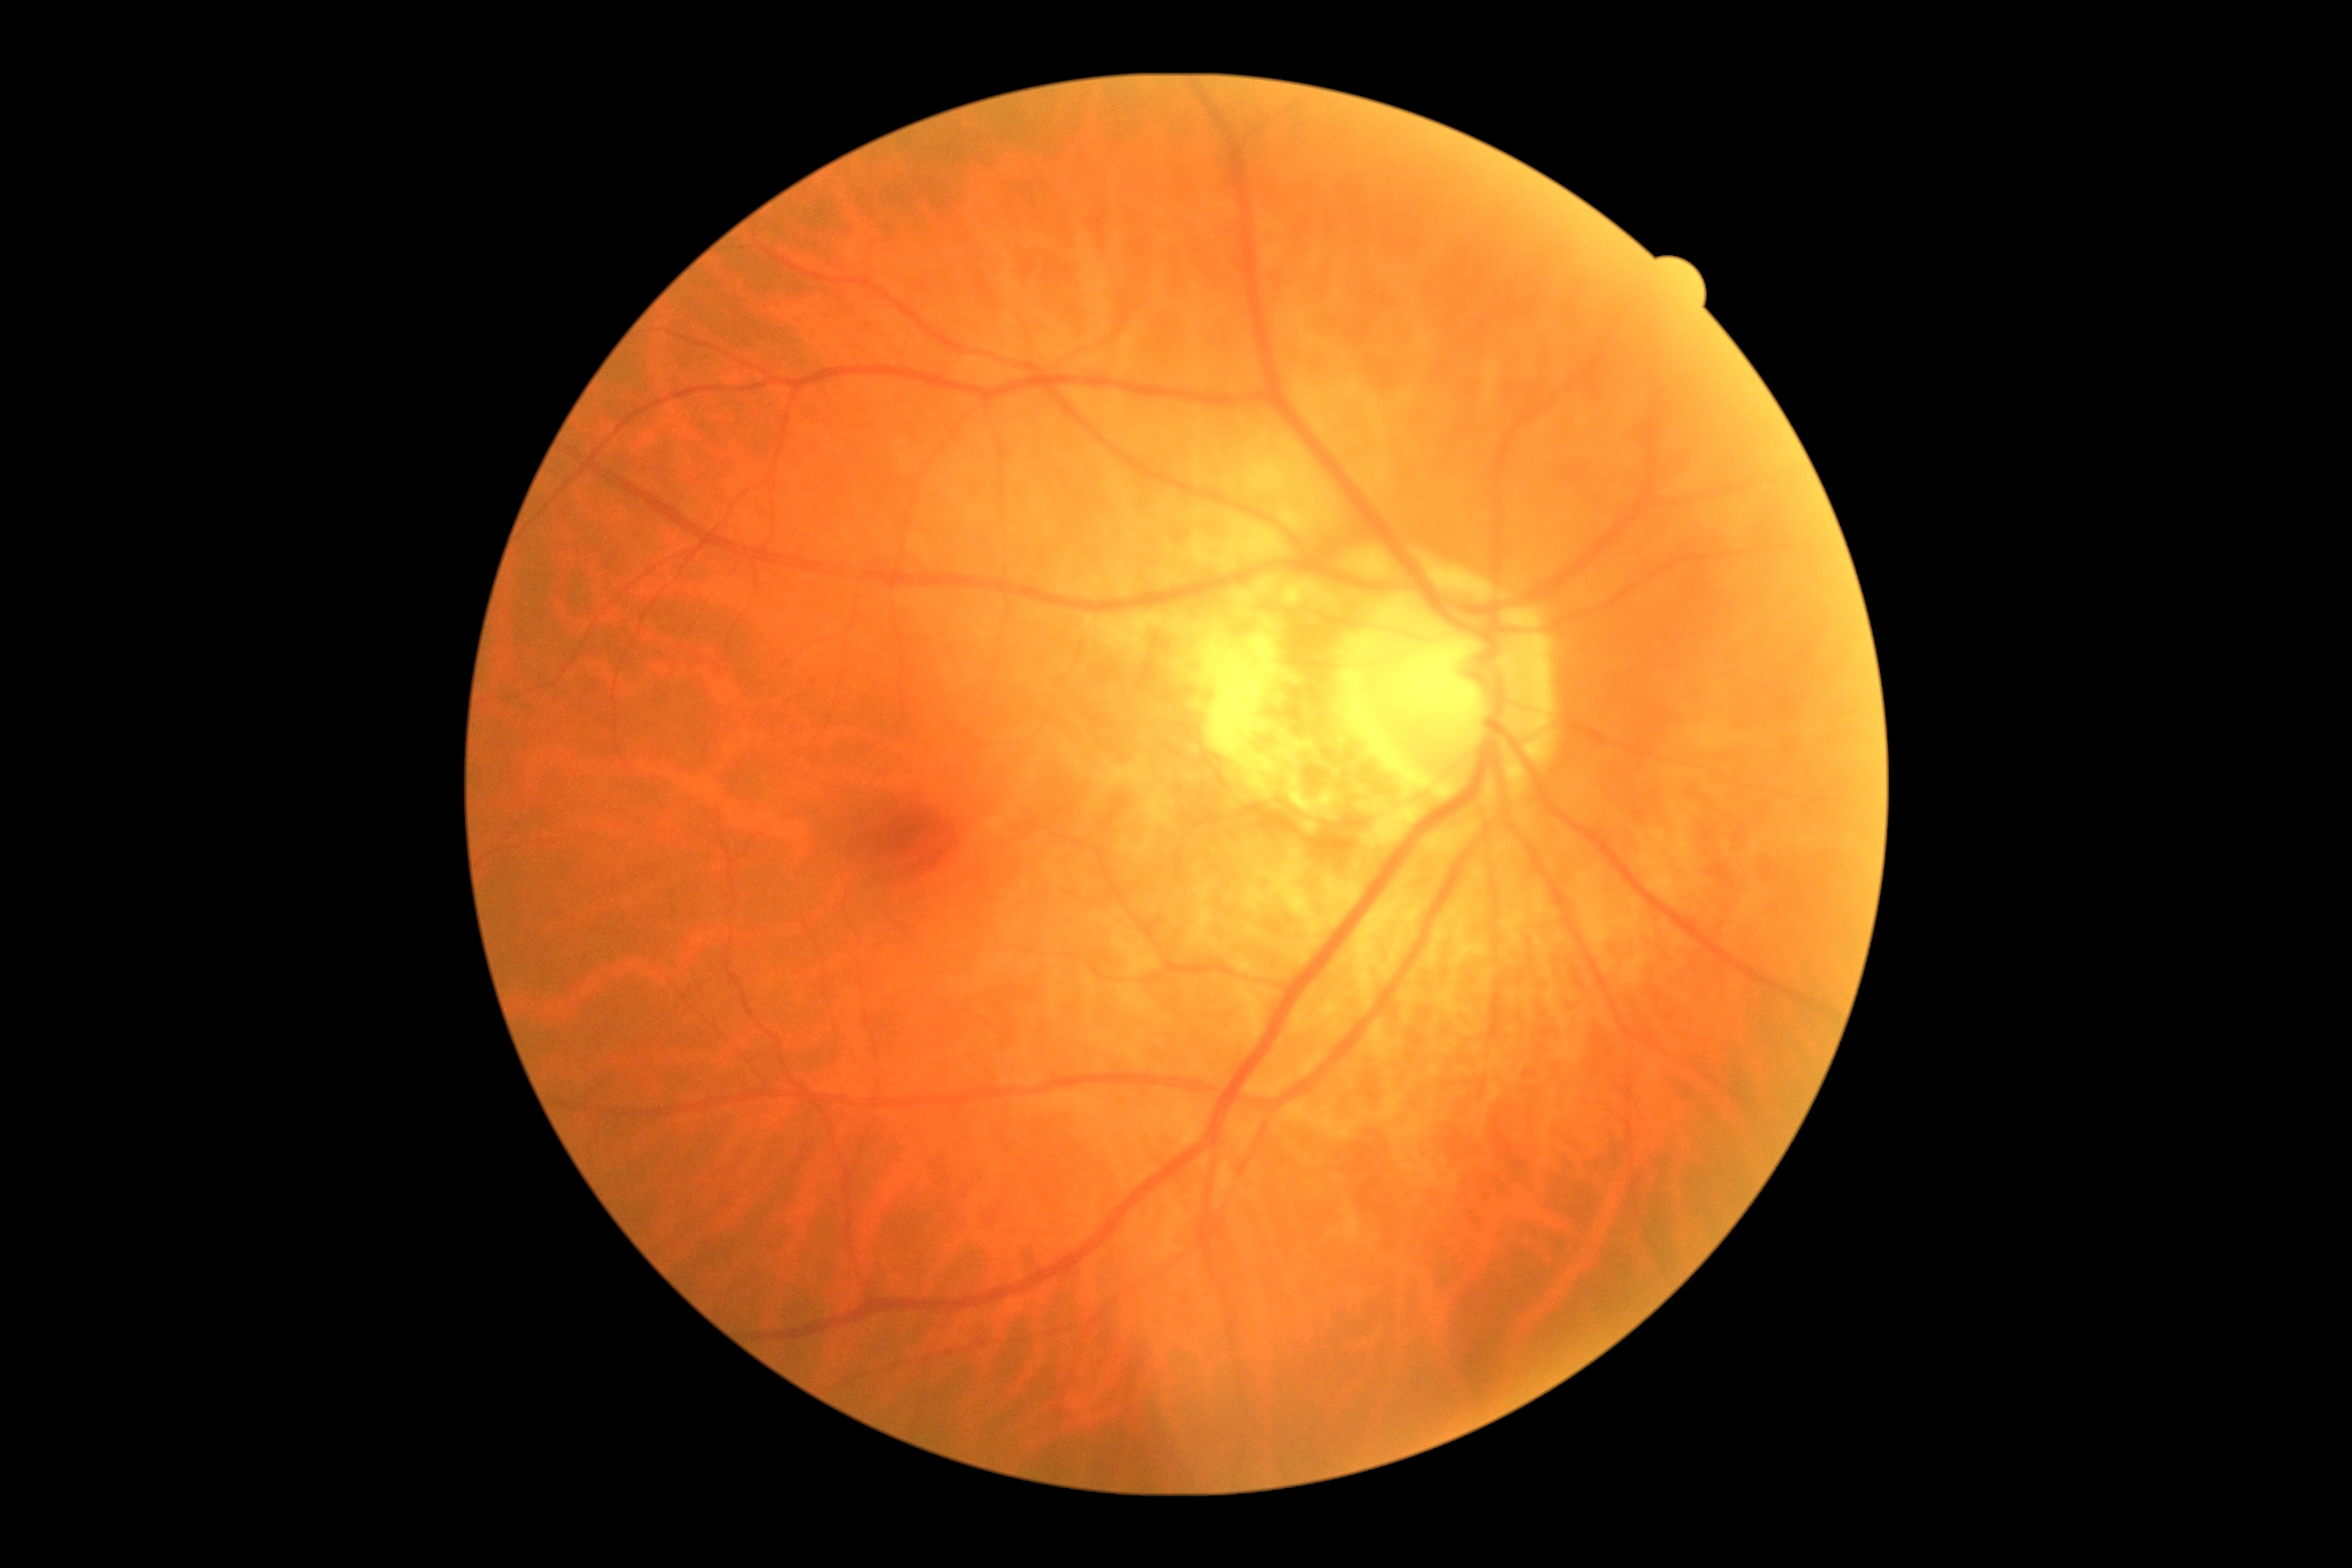
DR severity@0.